Acquired with a NIDEK AFC-230, nonmydriatic, 848x848
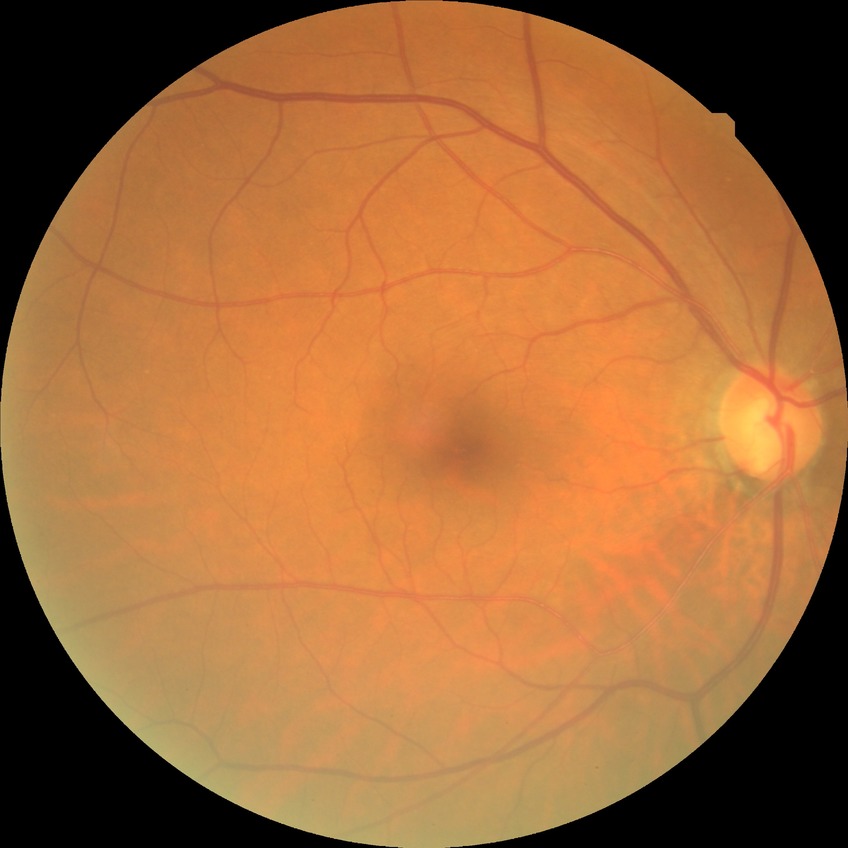

DR impression = negative for DR
DR stage = NDR